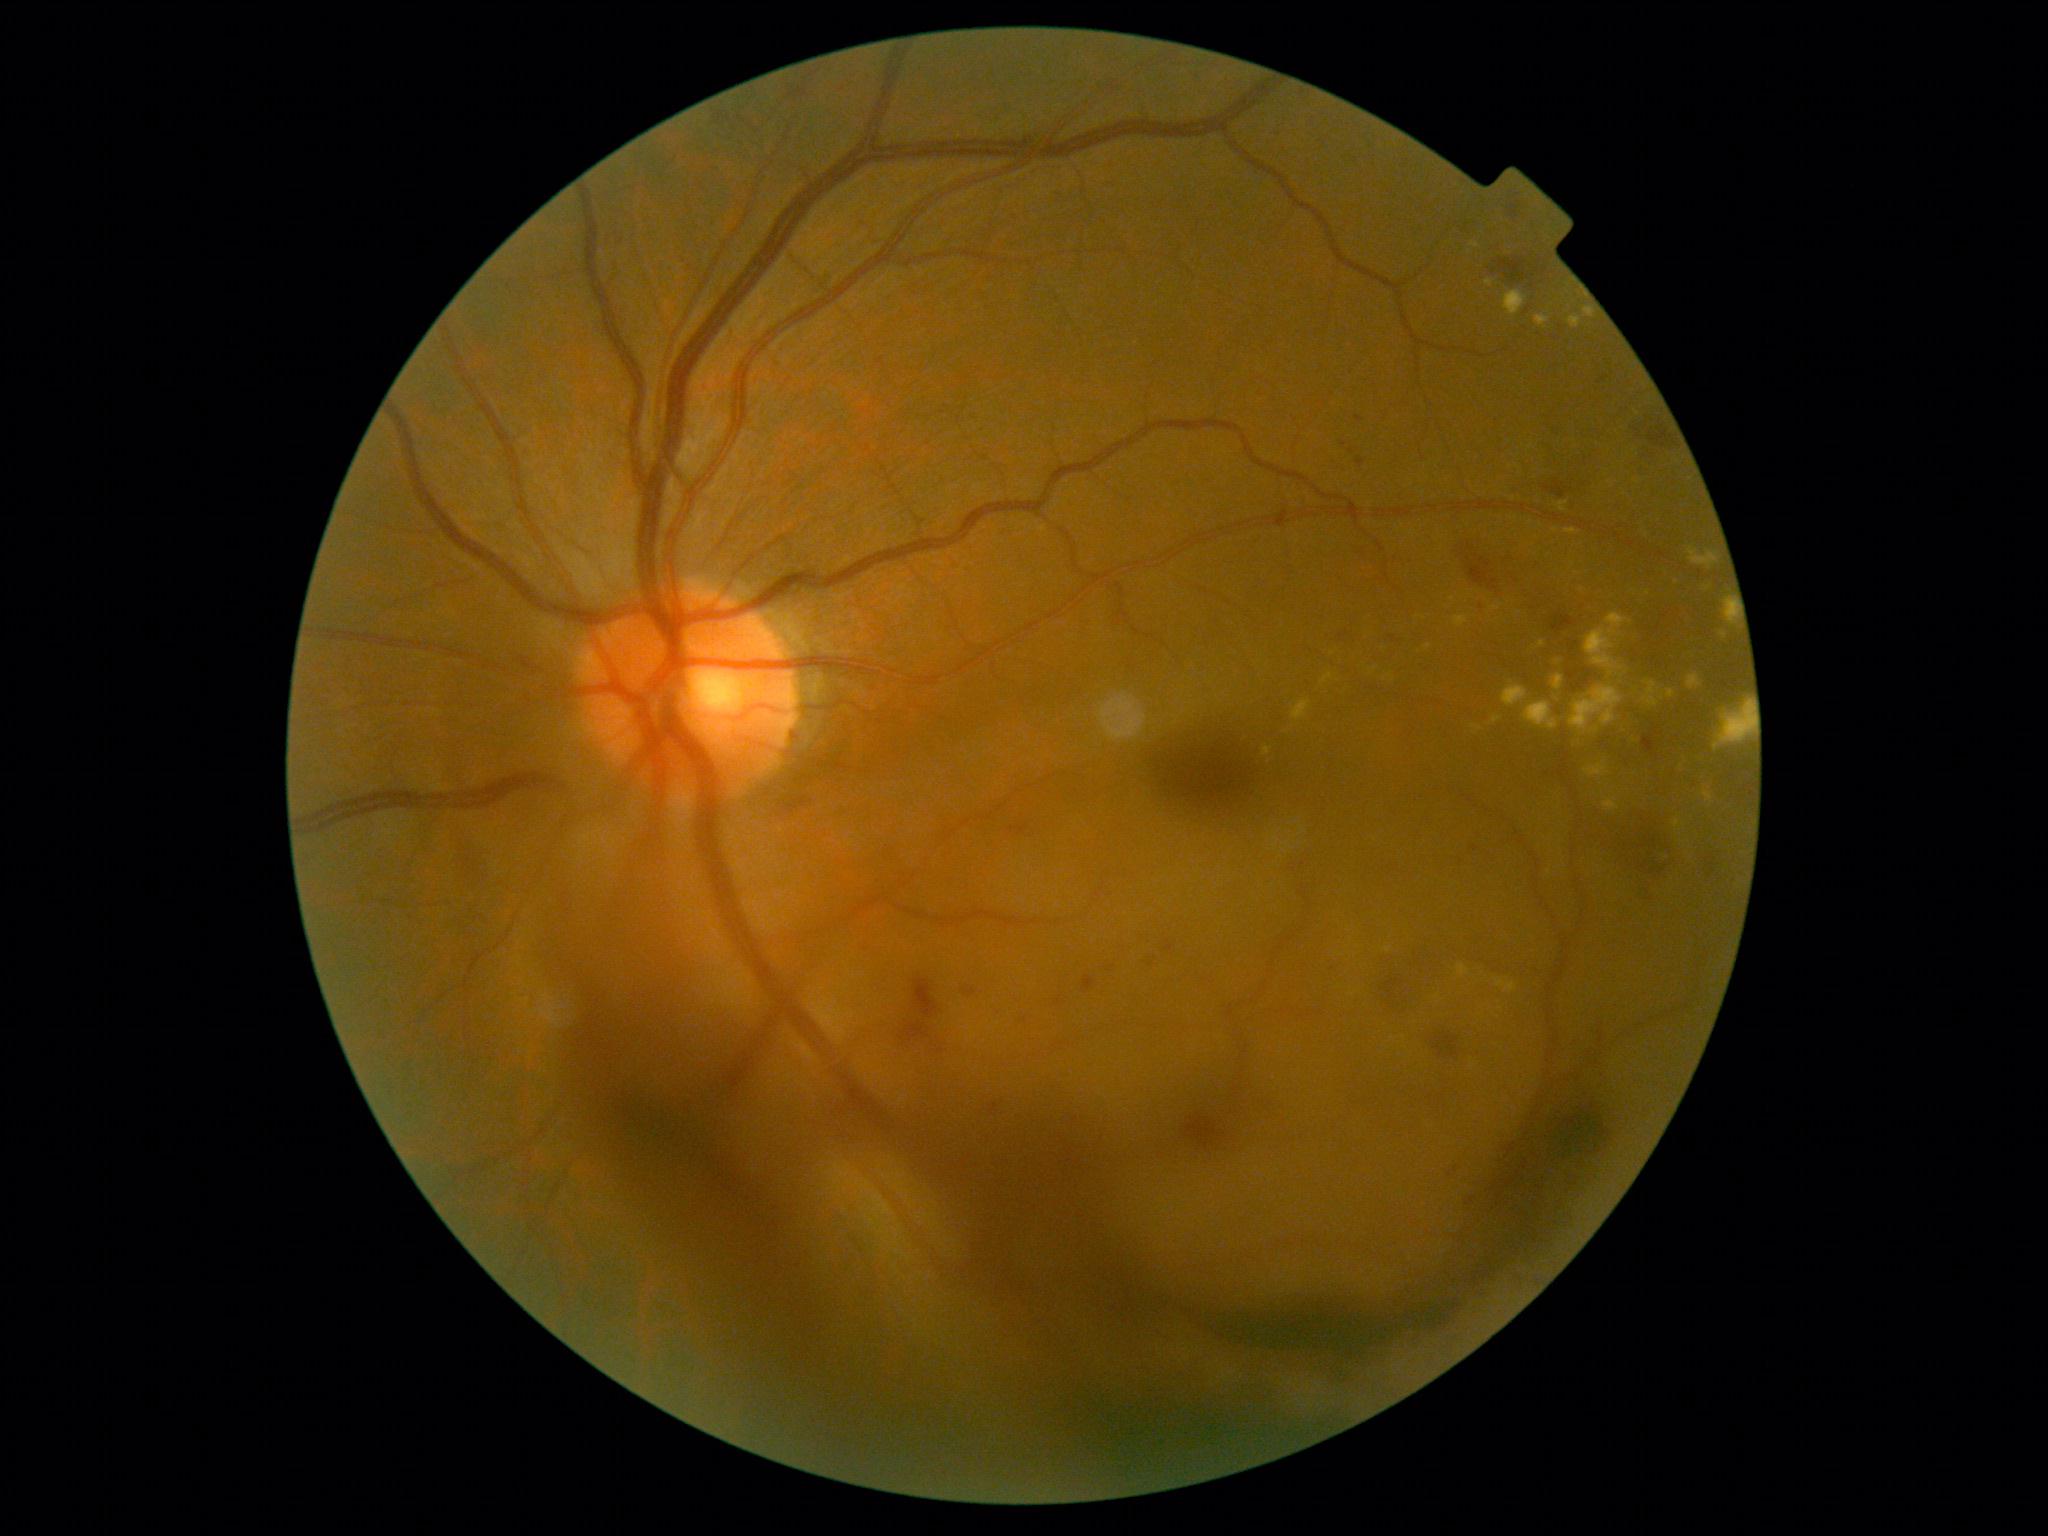 {
  "dr_grade": "4 (PDR)"
}